Color fundus photograph · NIDEK AFC-230 · 45 degree fundus photograph — 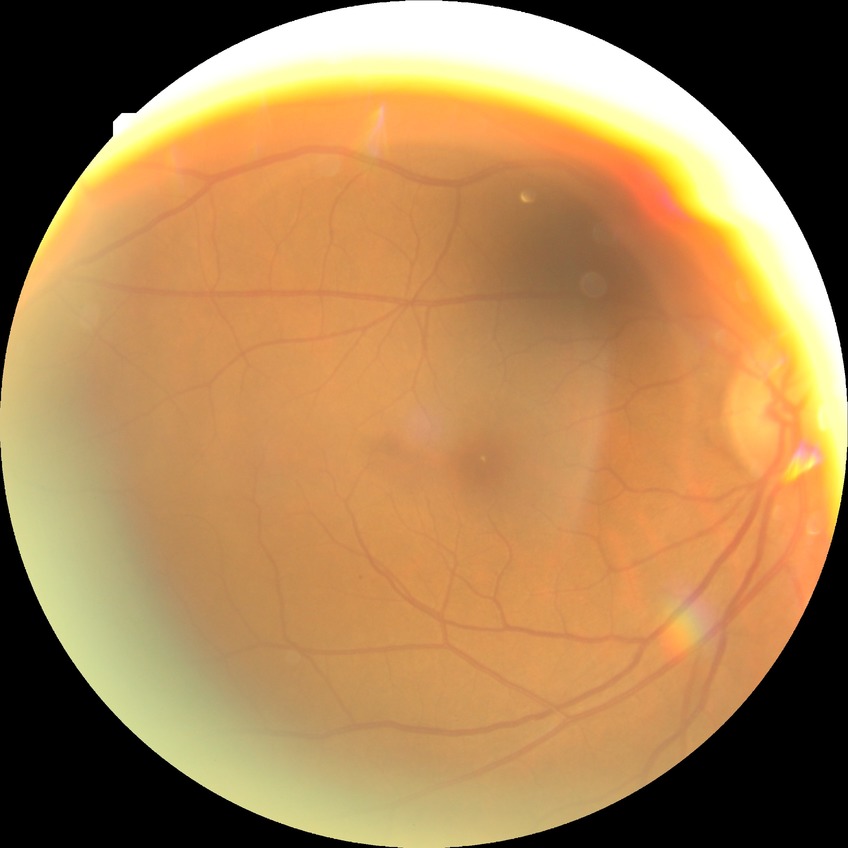

diabetic retinopathy stage = no diabetic retinopathy.